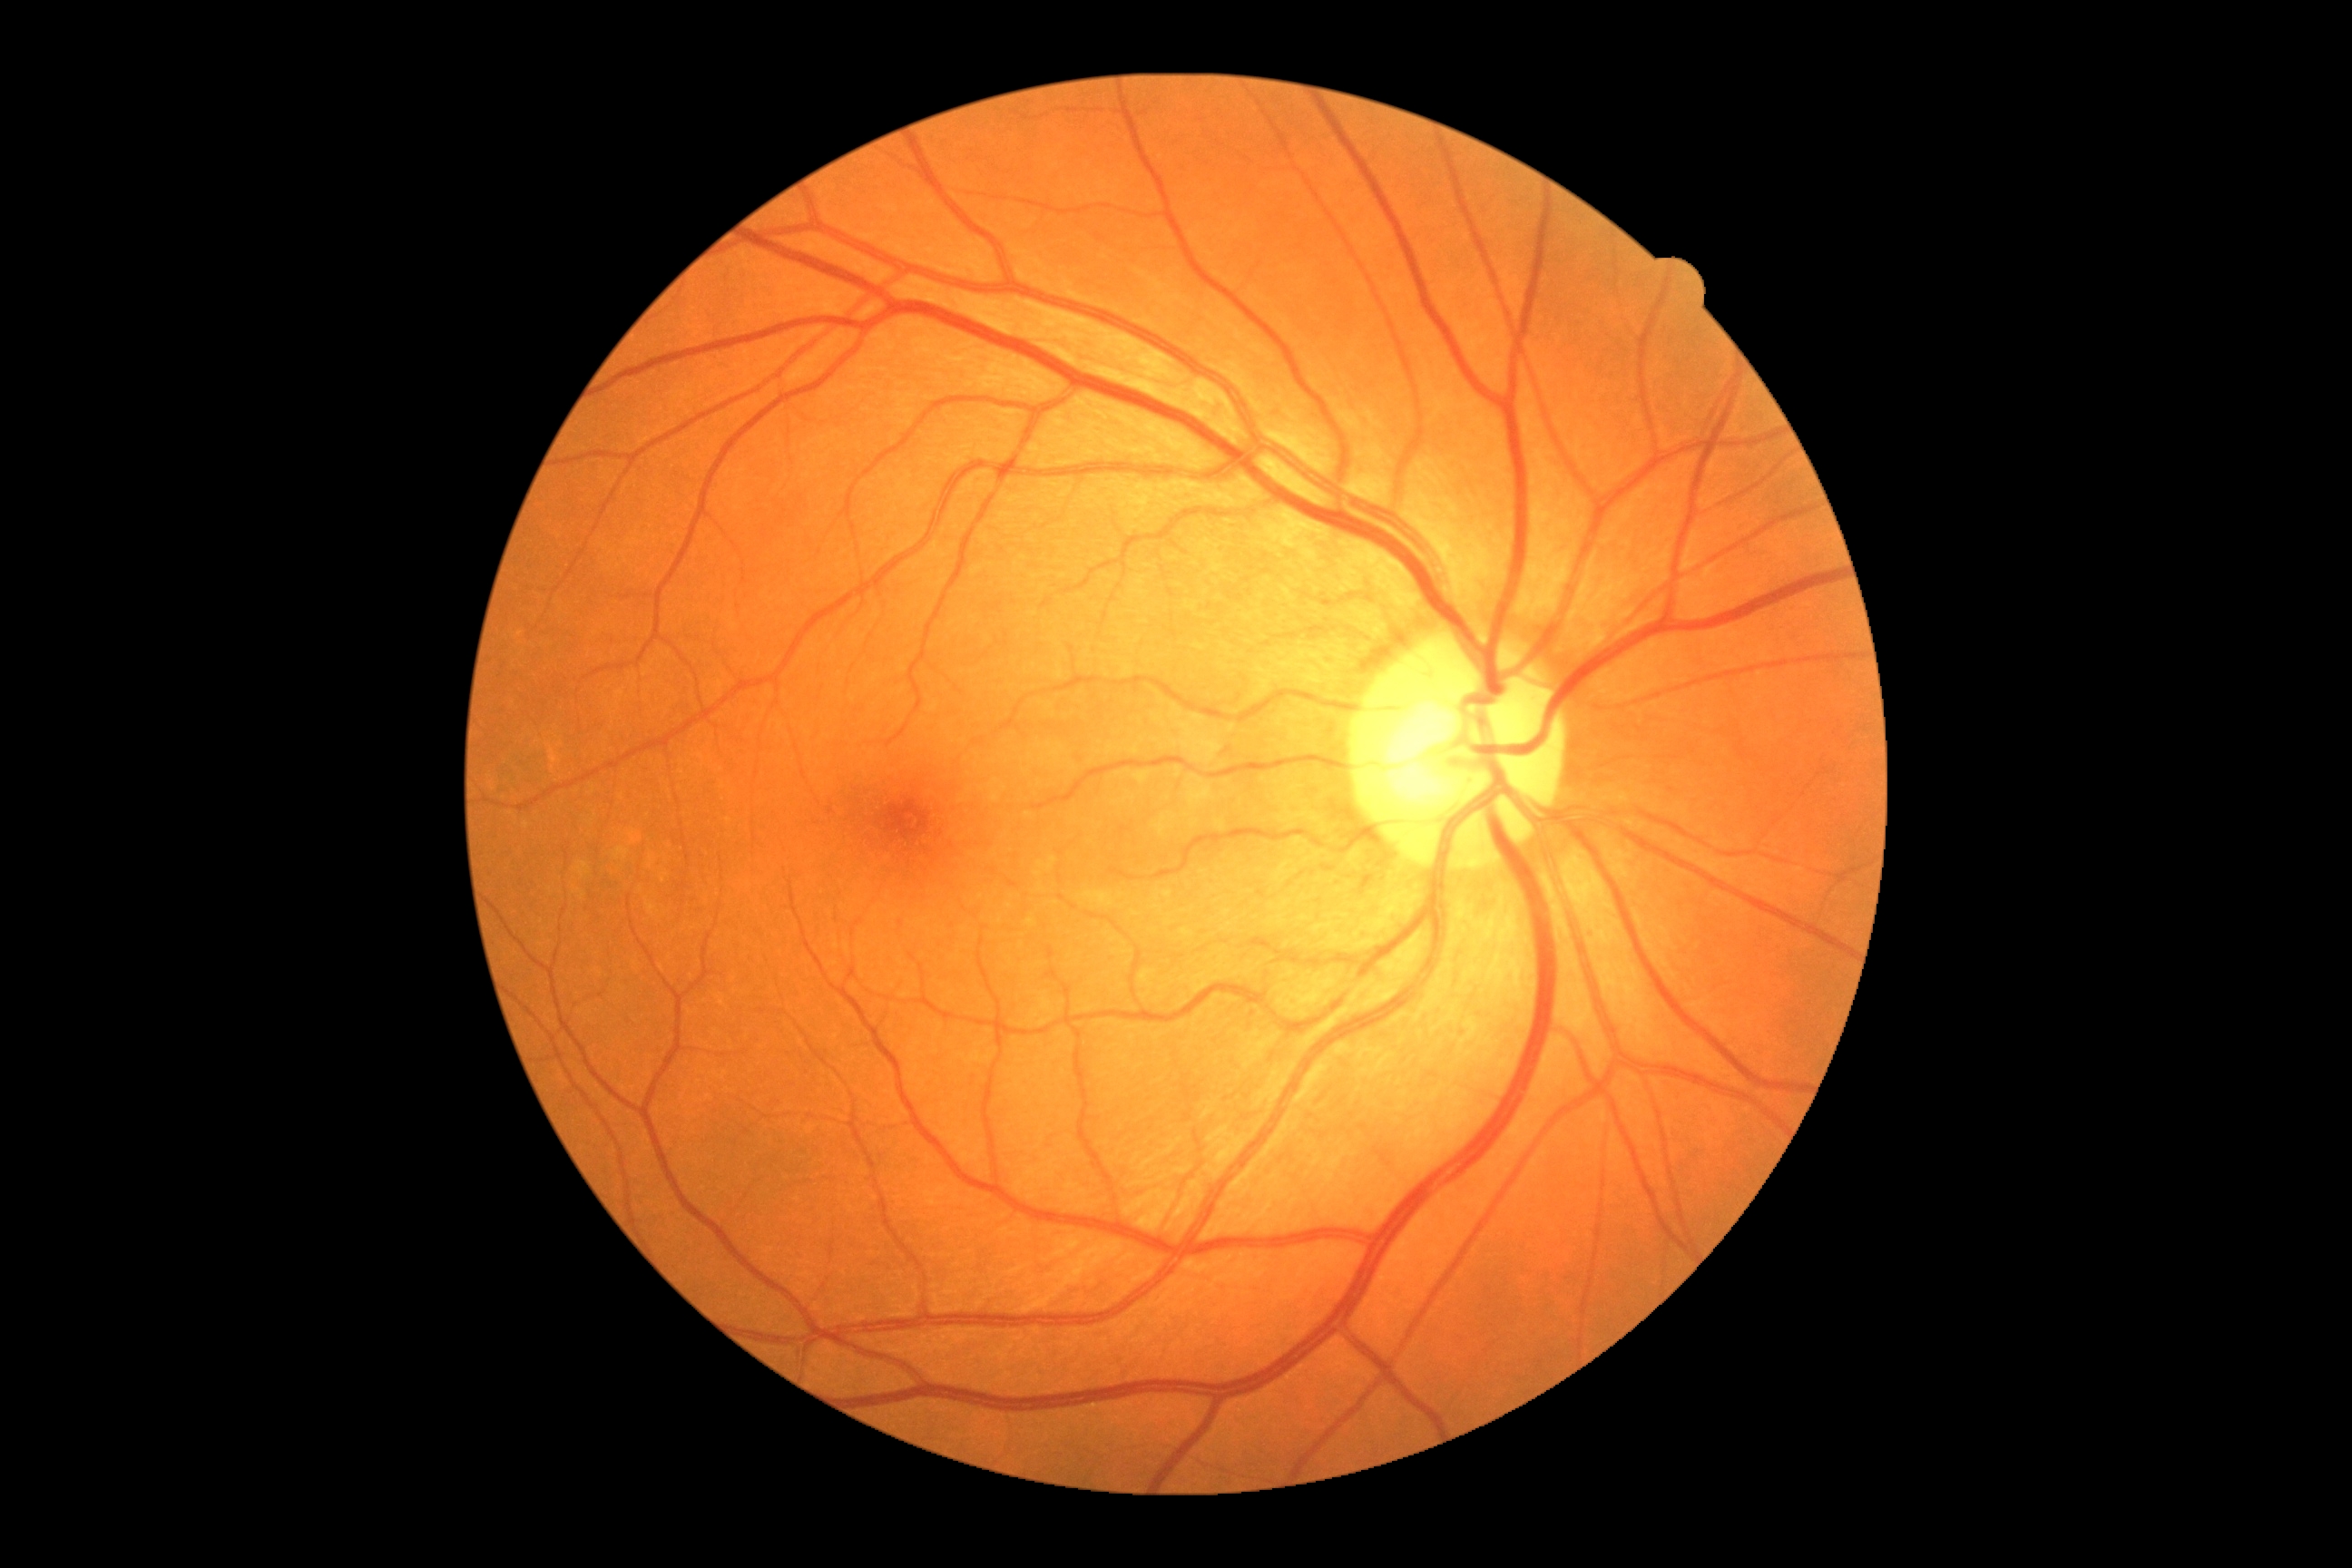

No DR findings.
Diabetic retinopathy severity: 0/4.